Retinal fundus photograph
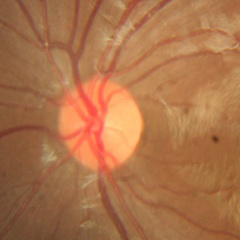 No signs of glaucoma.